Davis DR grading: 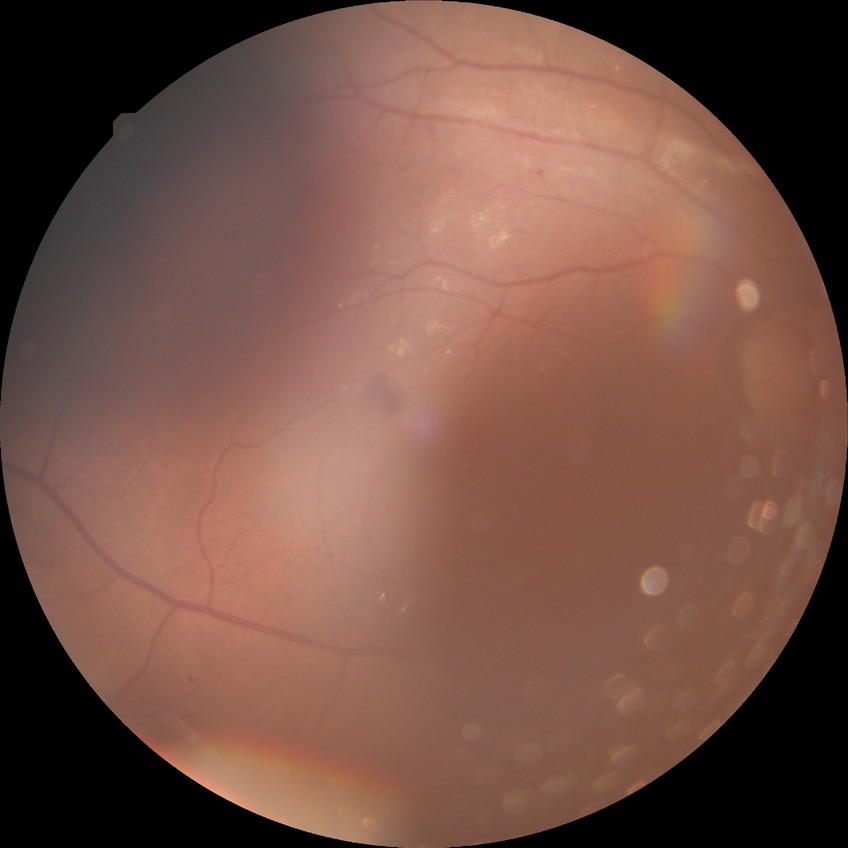

Diabetic retinopathy grade: simple diabetic retinopathy.